Wide-field fundus photograph of an infant; 1240 by 1240 pixels:
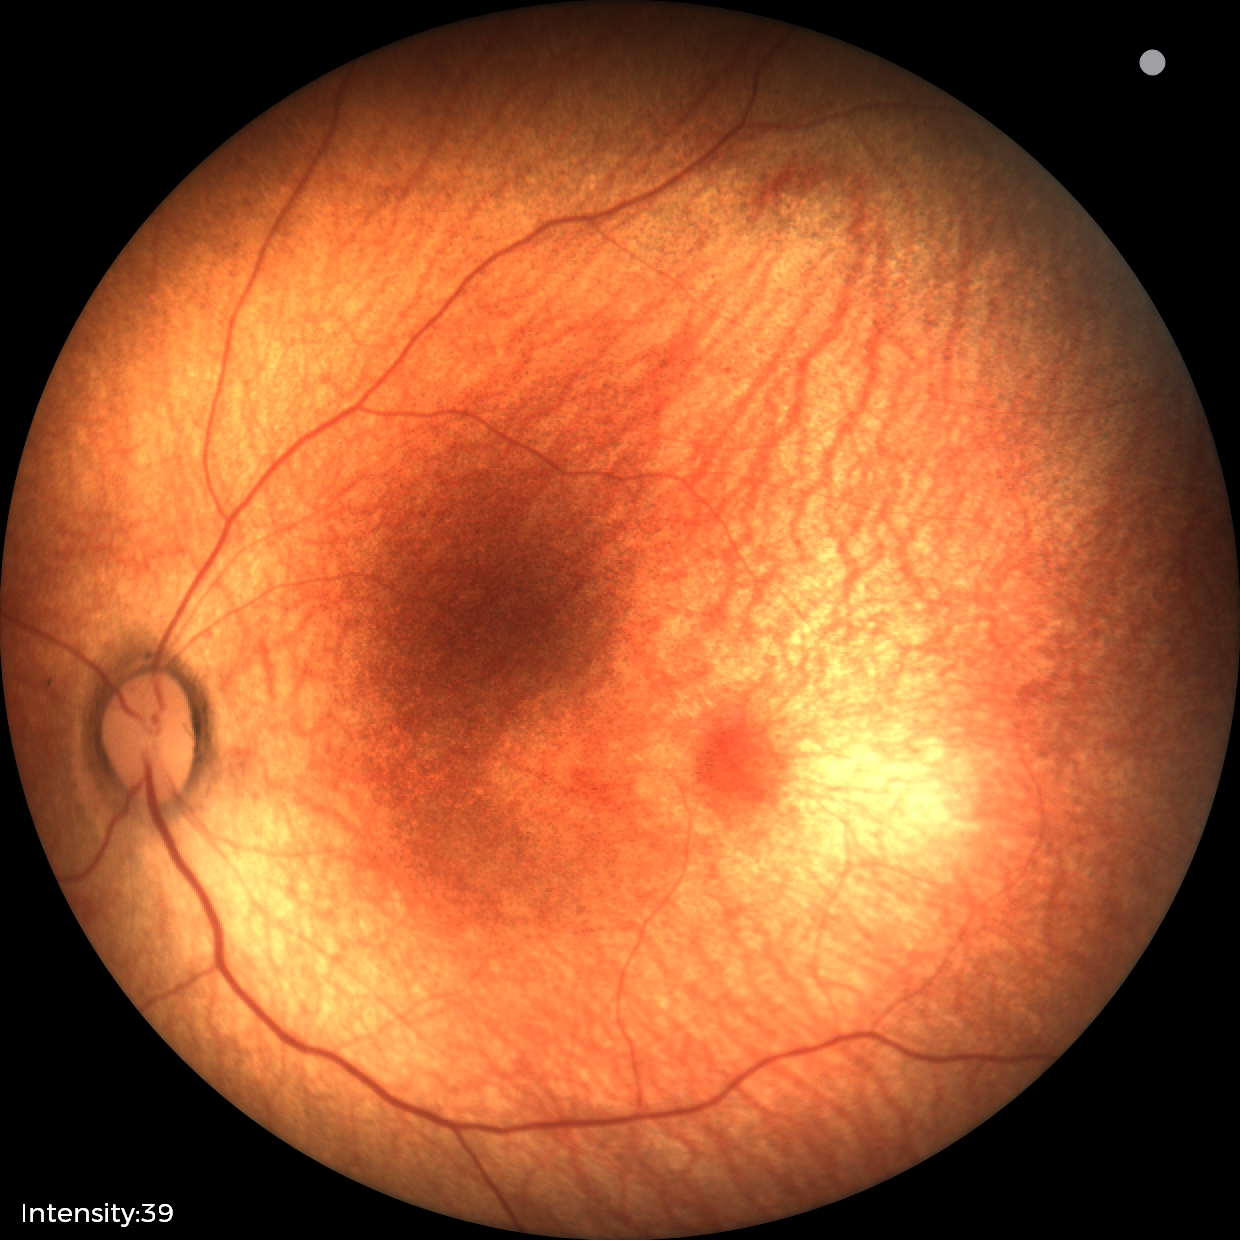

Screening diagnosis: normal retinal appearance.